Retinal fundus photograph; 2352x1568px; FOV: 45 degrees
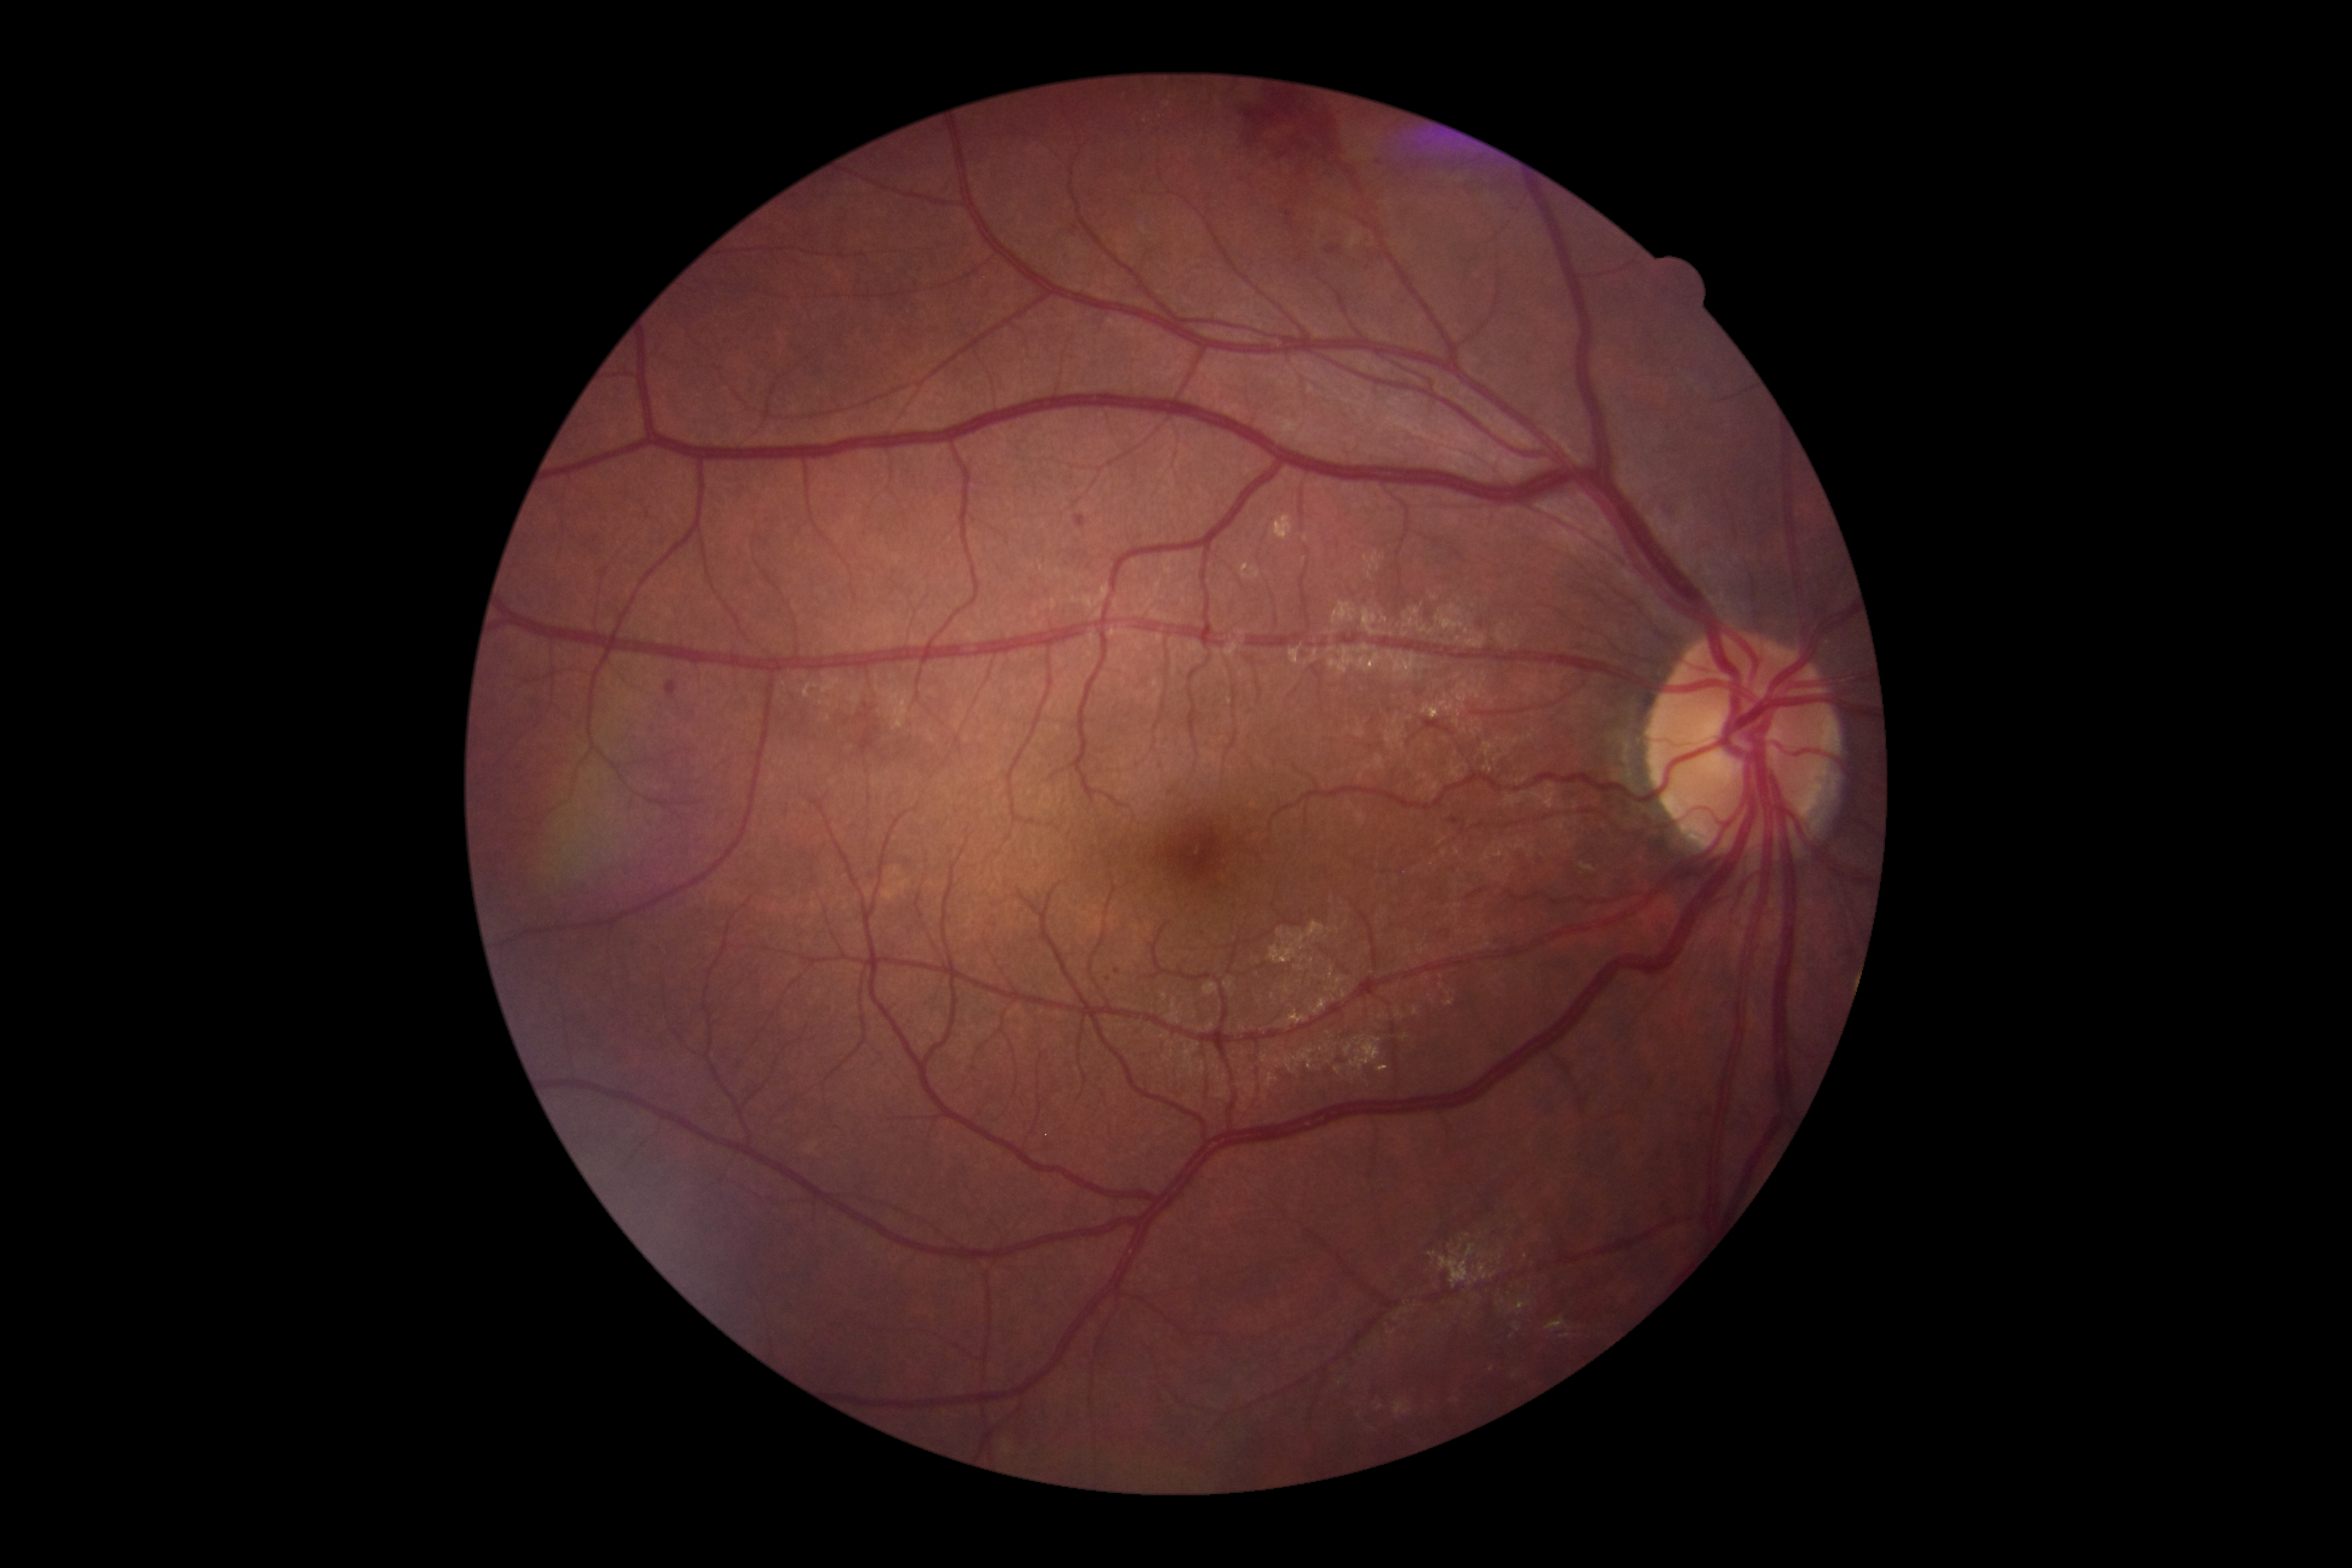

Annotations:
• DR grade — 2/4